Captured with the Phoenix ICON (100° field of view); wide-field fundus photograph from neonatal ROP screening.
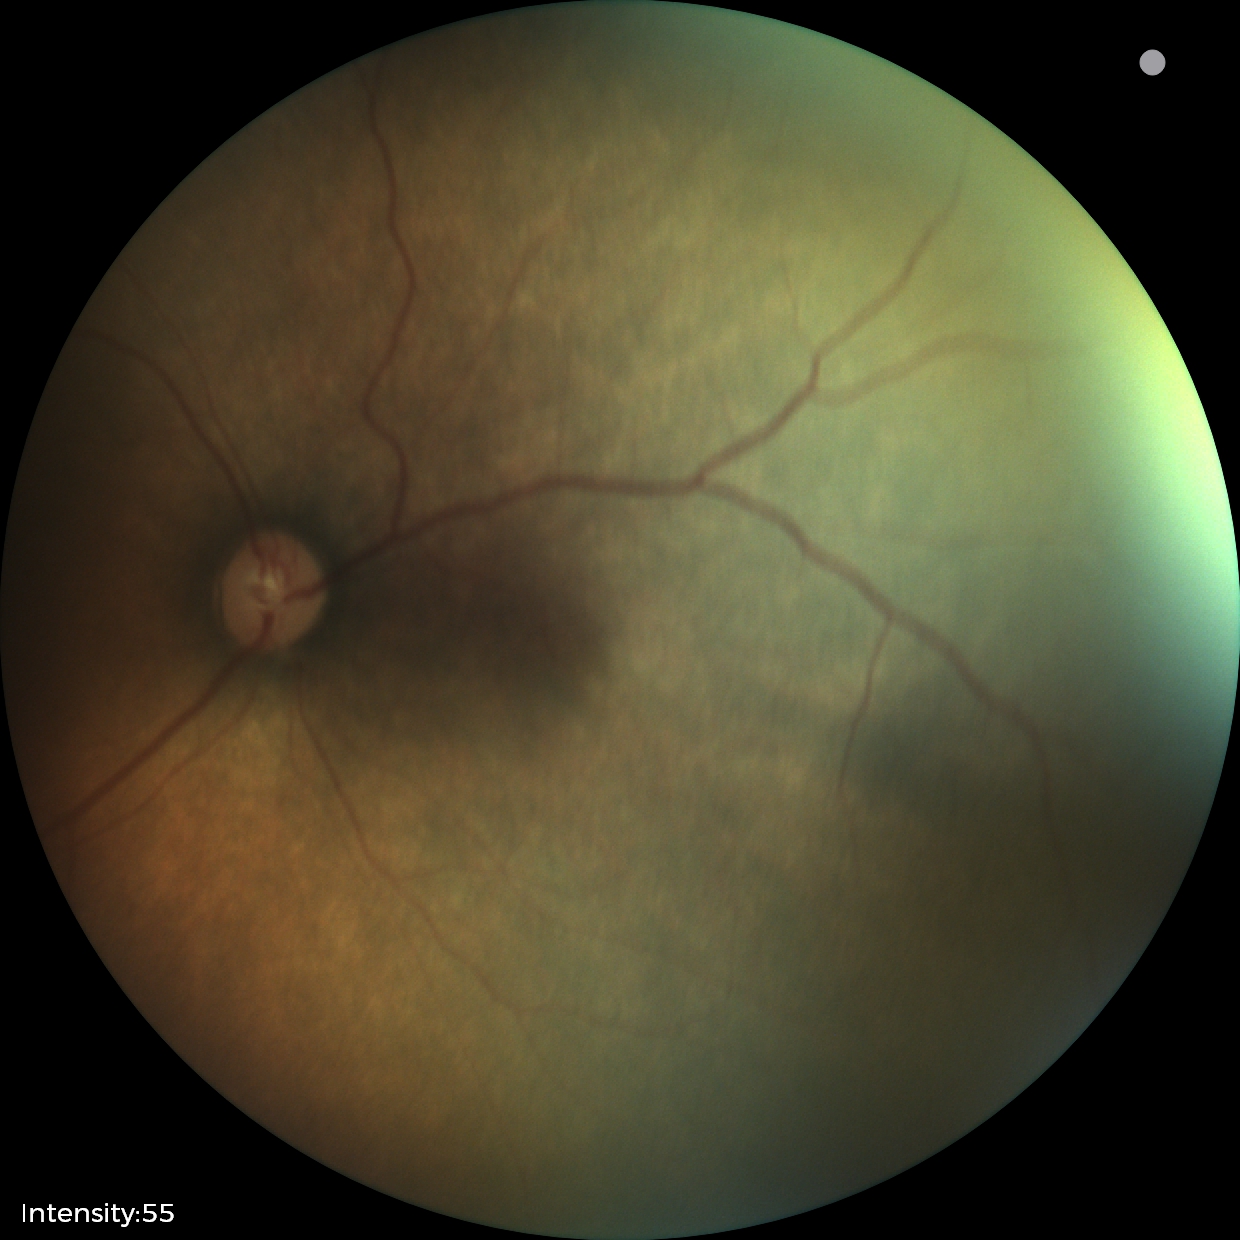 Plus form = absent | screening diagnosis = status post ROP.